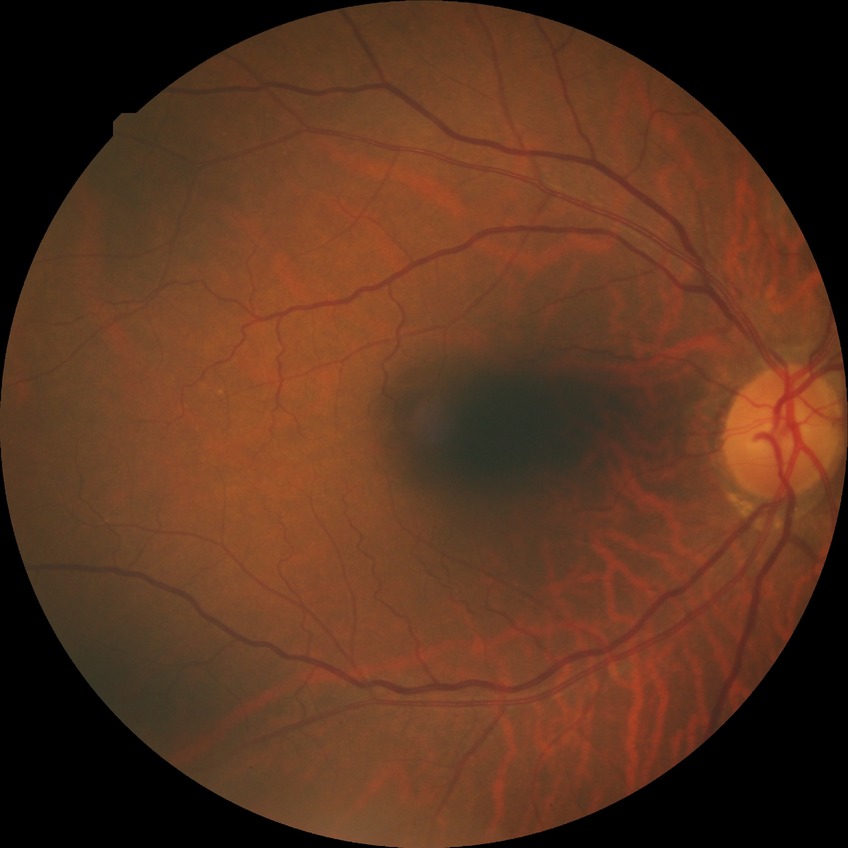

Modified Davis grading is no diabetic retinopathy.